45 degree fundus photograph. Acquired with a NIDEK AFC-230. No pharmacologic dilation. Retinal fundus photograph.
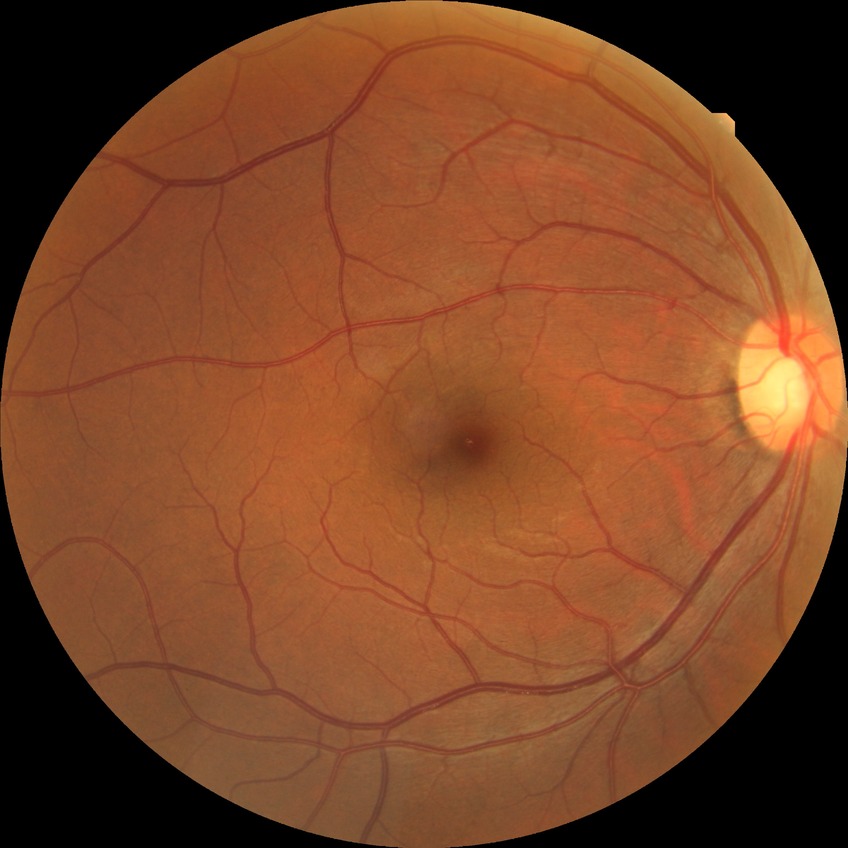 The retinopathy is classified as non-proliferative diabetic retinopathy. Retinopathy grade: simple diabetic retinopathy.